2352x1568px. FOV: 45 degrees: 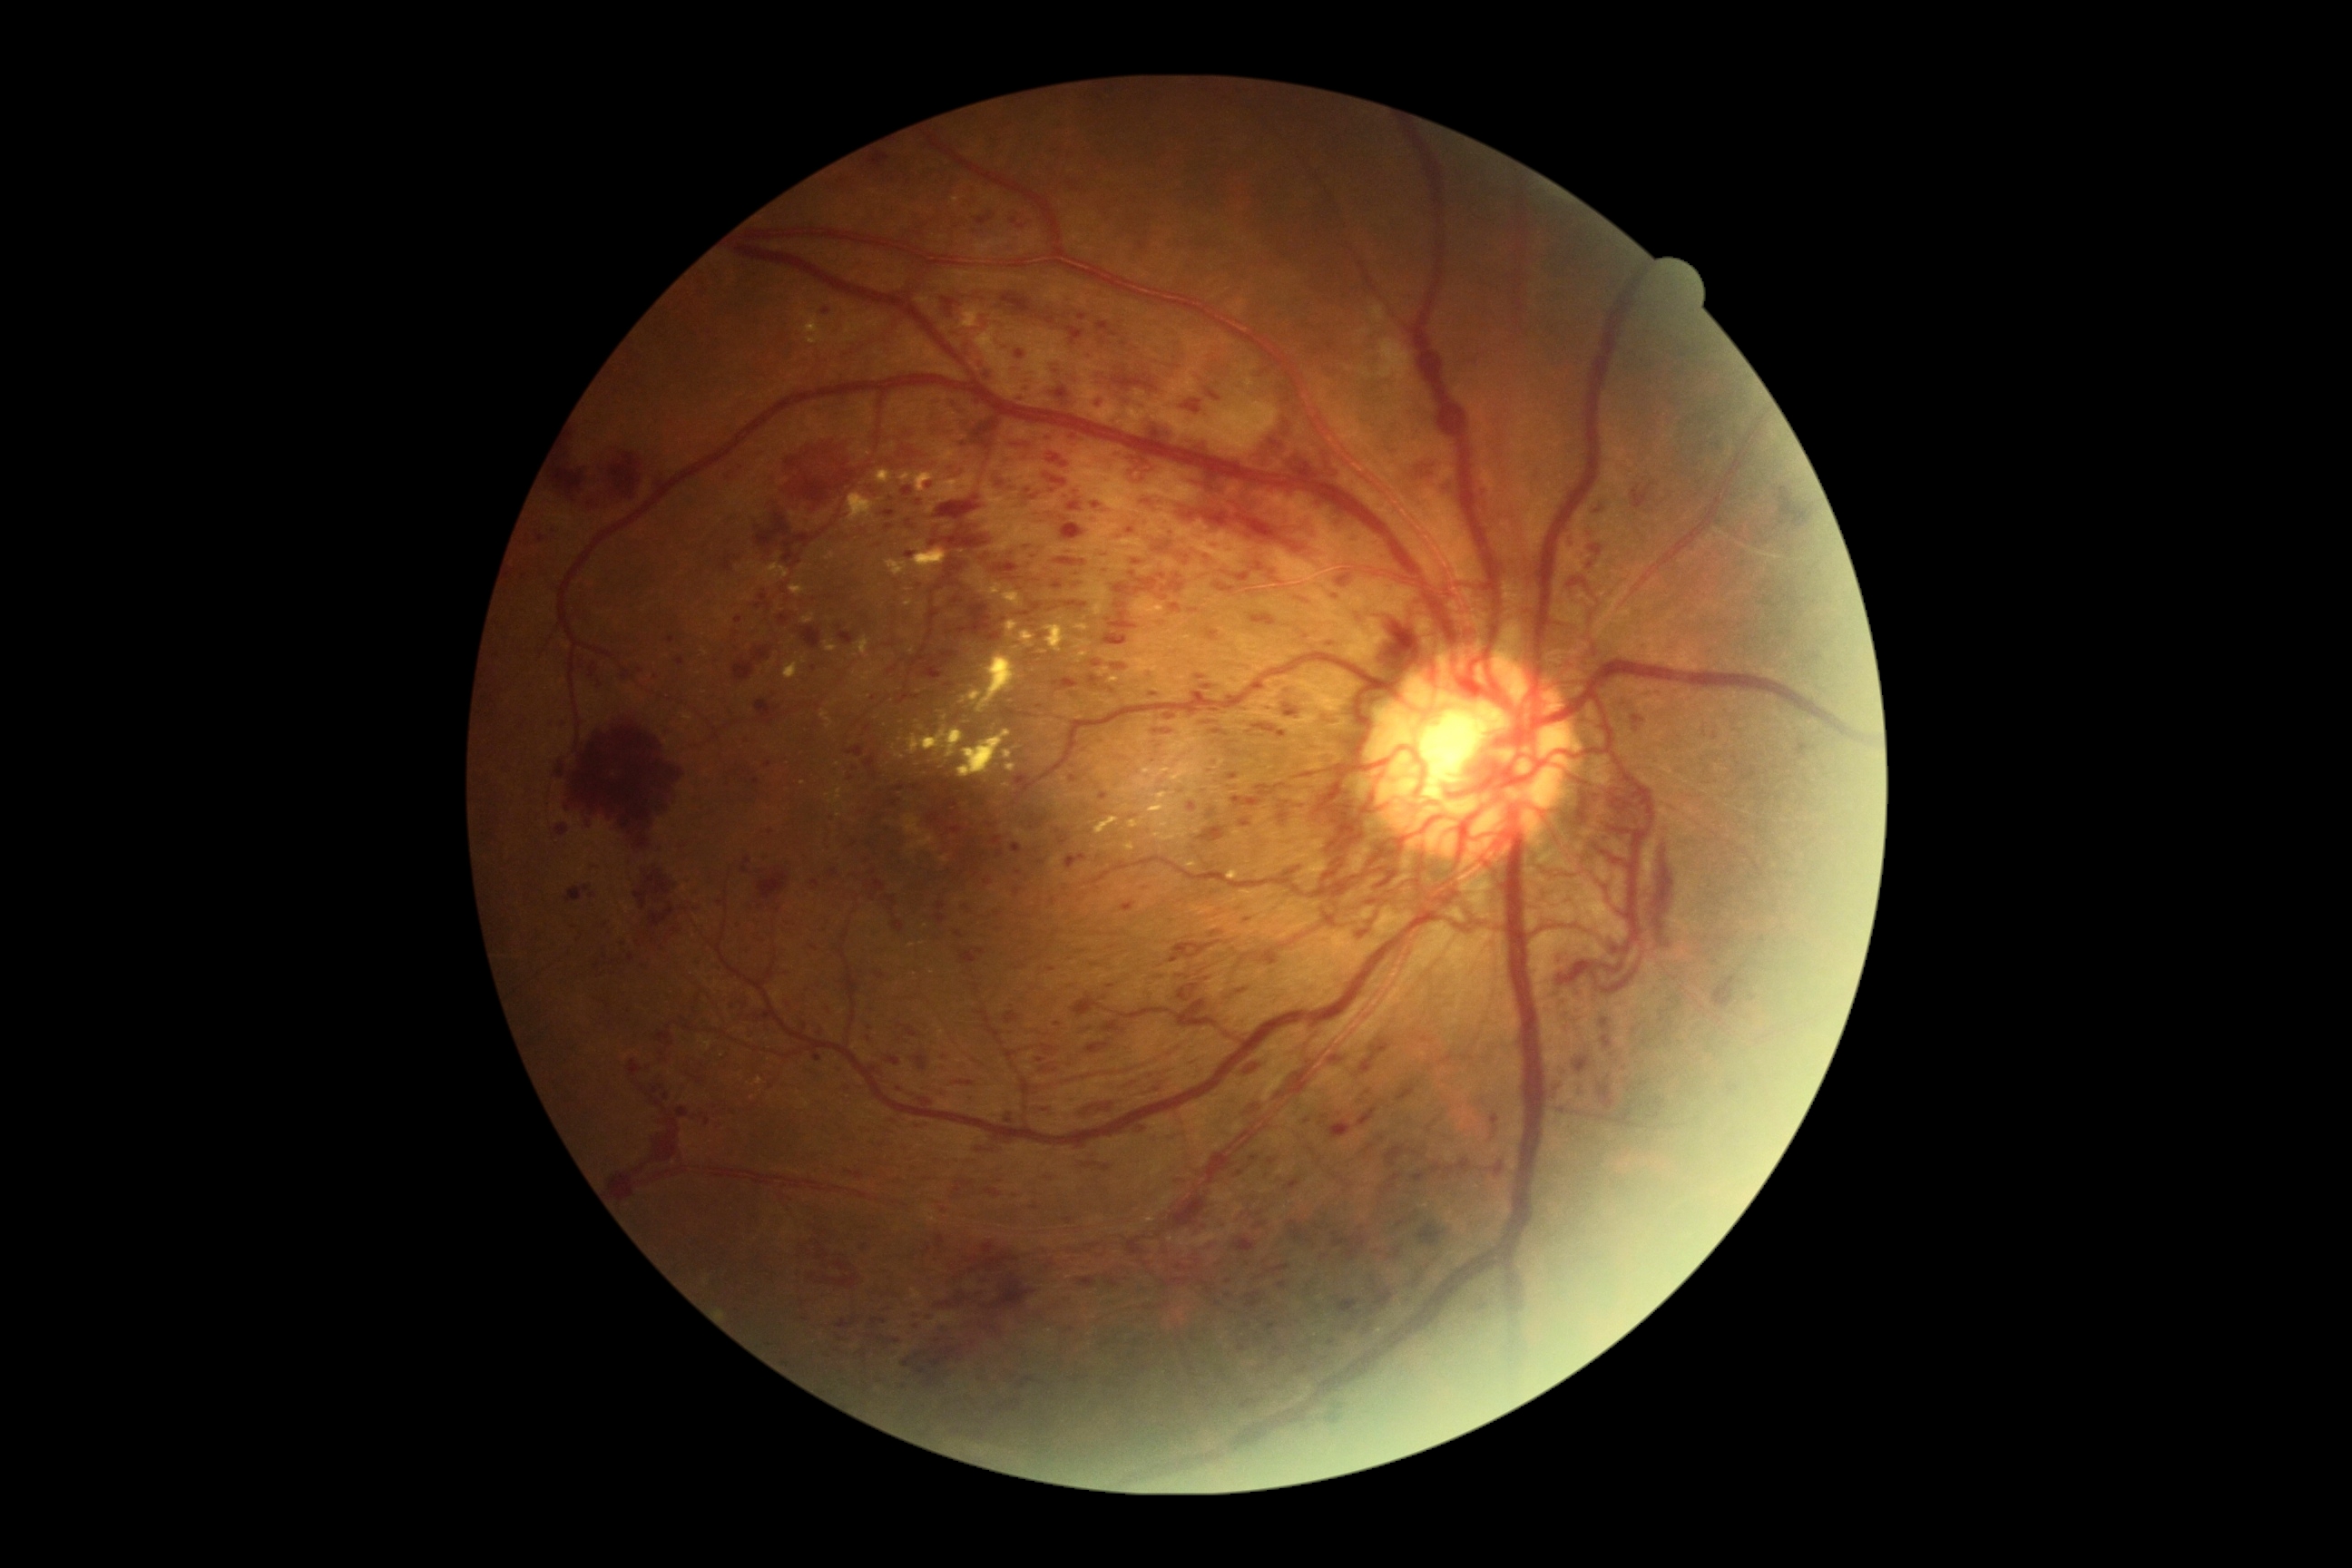
Diabetic retinopathy (DR) is 4 — neovascularization and/or vitreous/pre-retinal hemorrhage
Lesions identified (partial list):
hemorrhages (HEs) (more not shown): 1632 484 1654 509 | 975 215 994 226 | 1279 803 1289 810 | 1153 729 1173 734 | 863 756 877 779 | 1244 1064 1260 1075 | 629 1061 643 1077 | 1289 1220 1304 1240 | 1378 612 1418 642 | 1083 1162 1099 1168 | 1357 1108 1378 1128 | 816 1242 861 1289 | 1231 750 1239 756 | 1113 375 1159 391 | 1353 928 1373 936
Smaller HEs around <point>868, 728</point> | <point>803, 1304</point> | <point>866, 1386</point> | <point>1663, 1021</point>